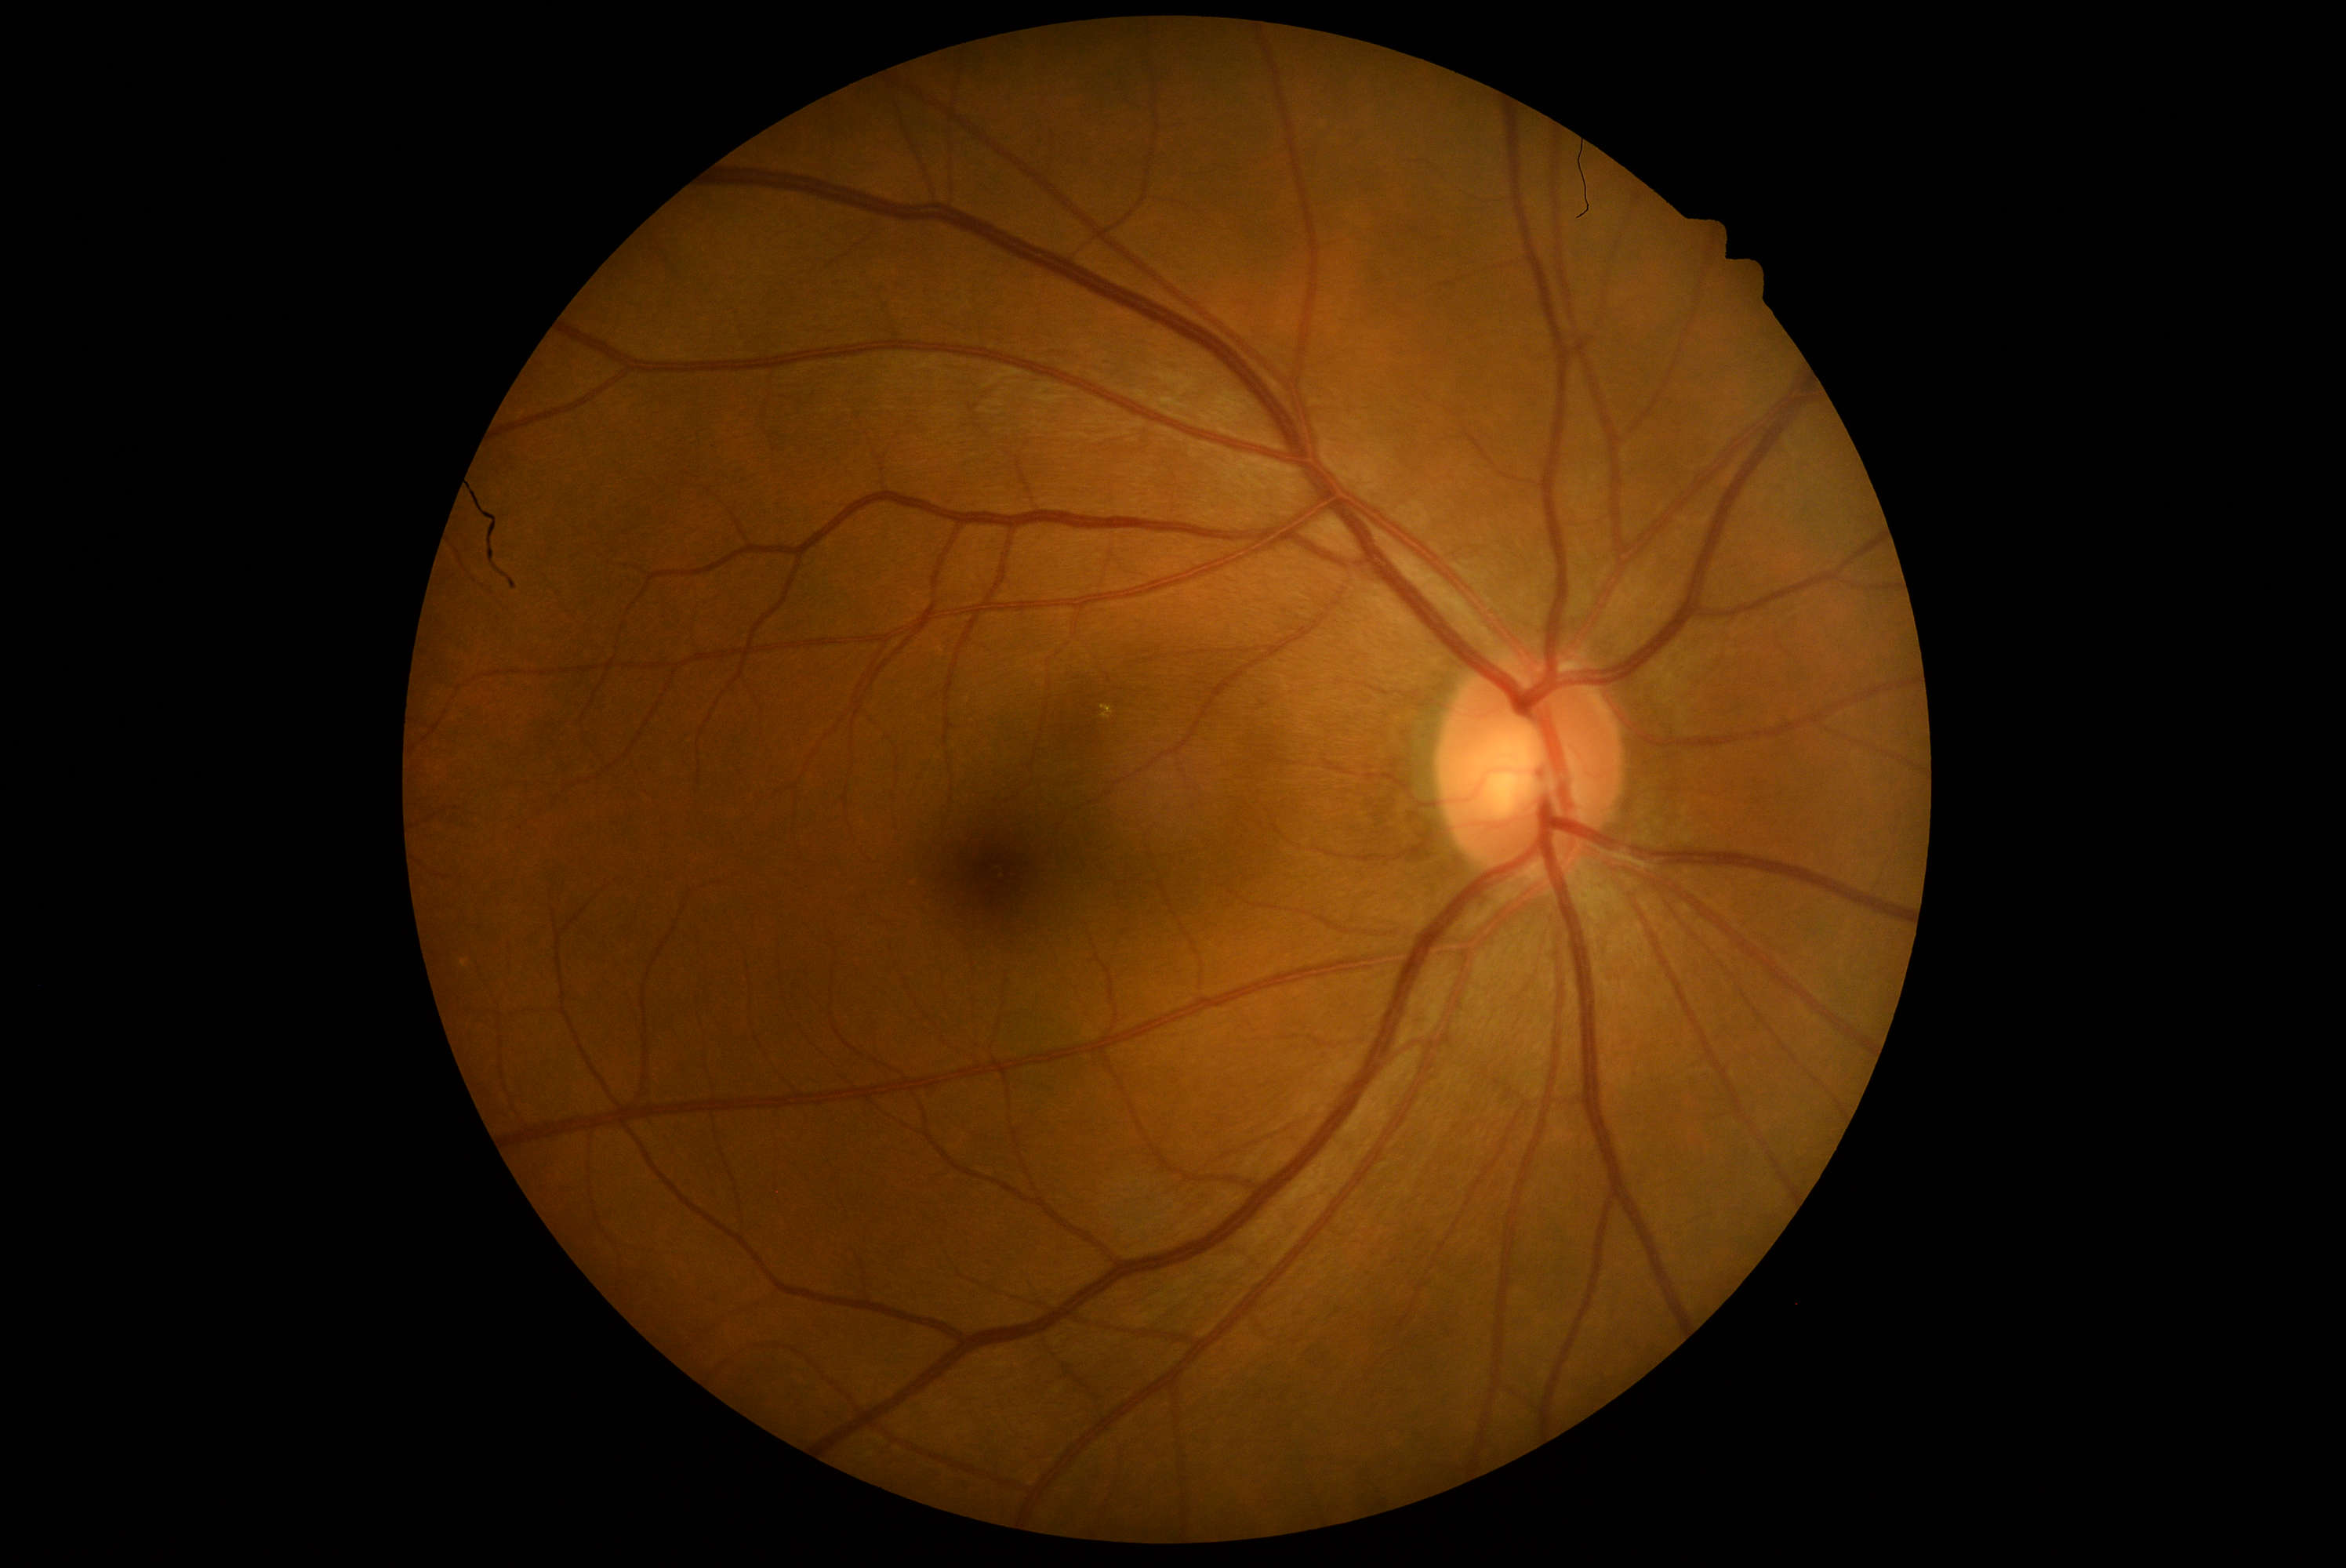 DR stage: no apparent retinopathy (grade 0). No DR findings.